Diabetic retinopathy graded by the modified Davis classification
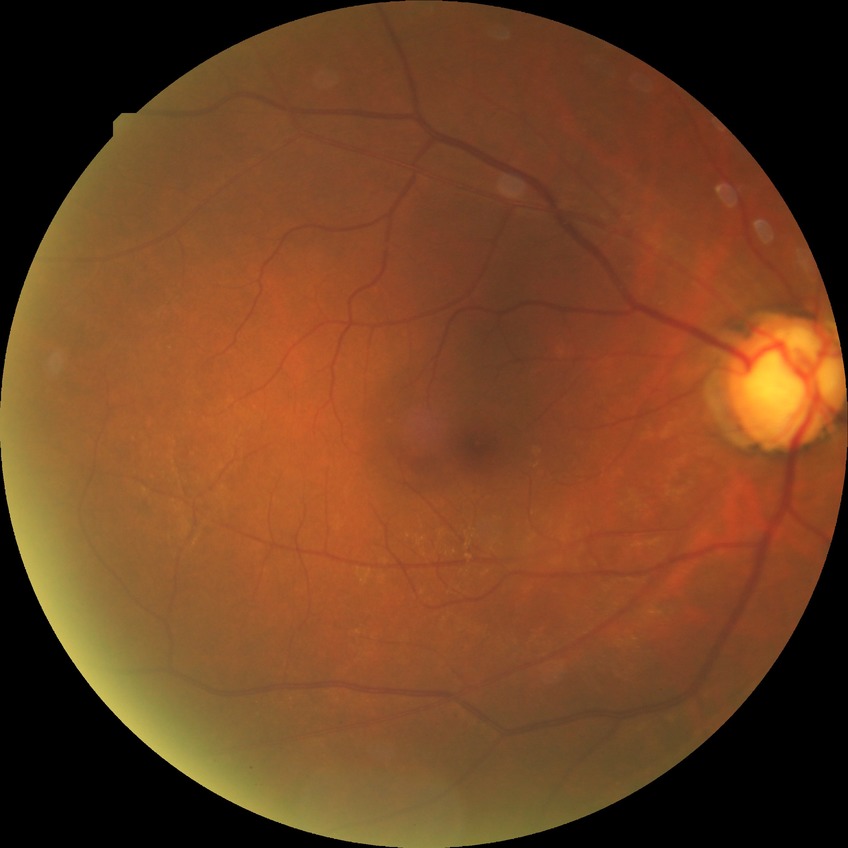

Diabetic retinopathy (DR) is simple diabetic retinopathy (SDR).